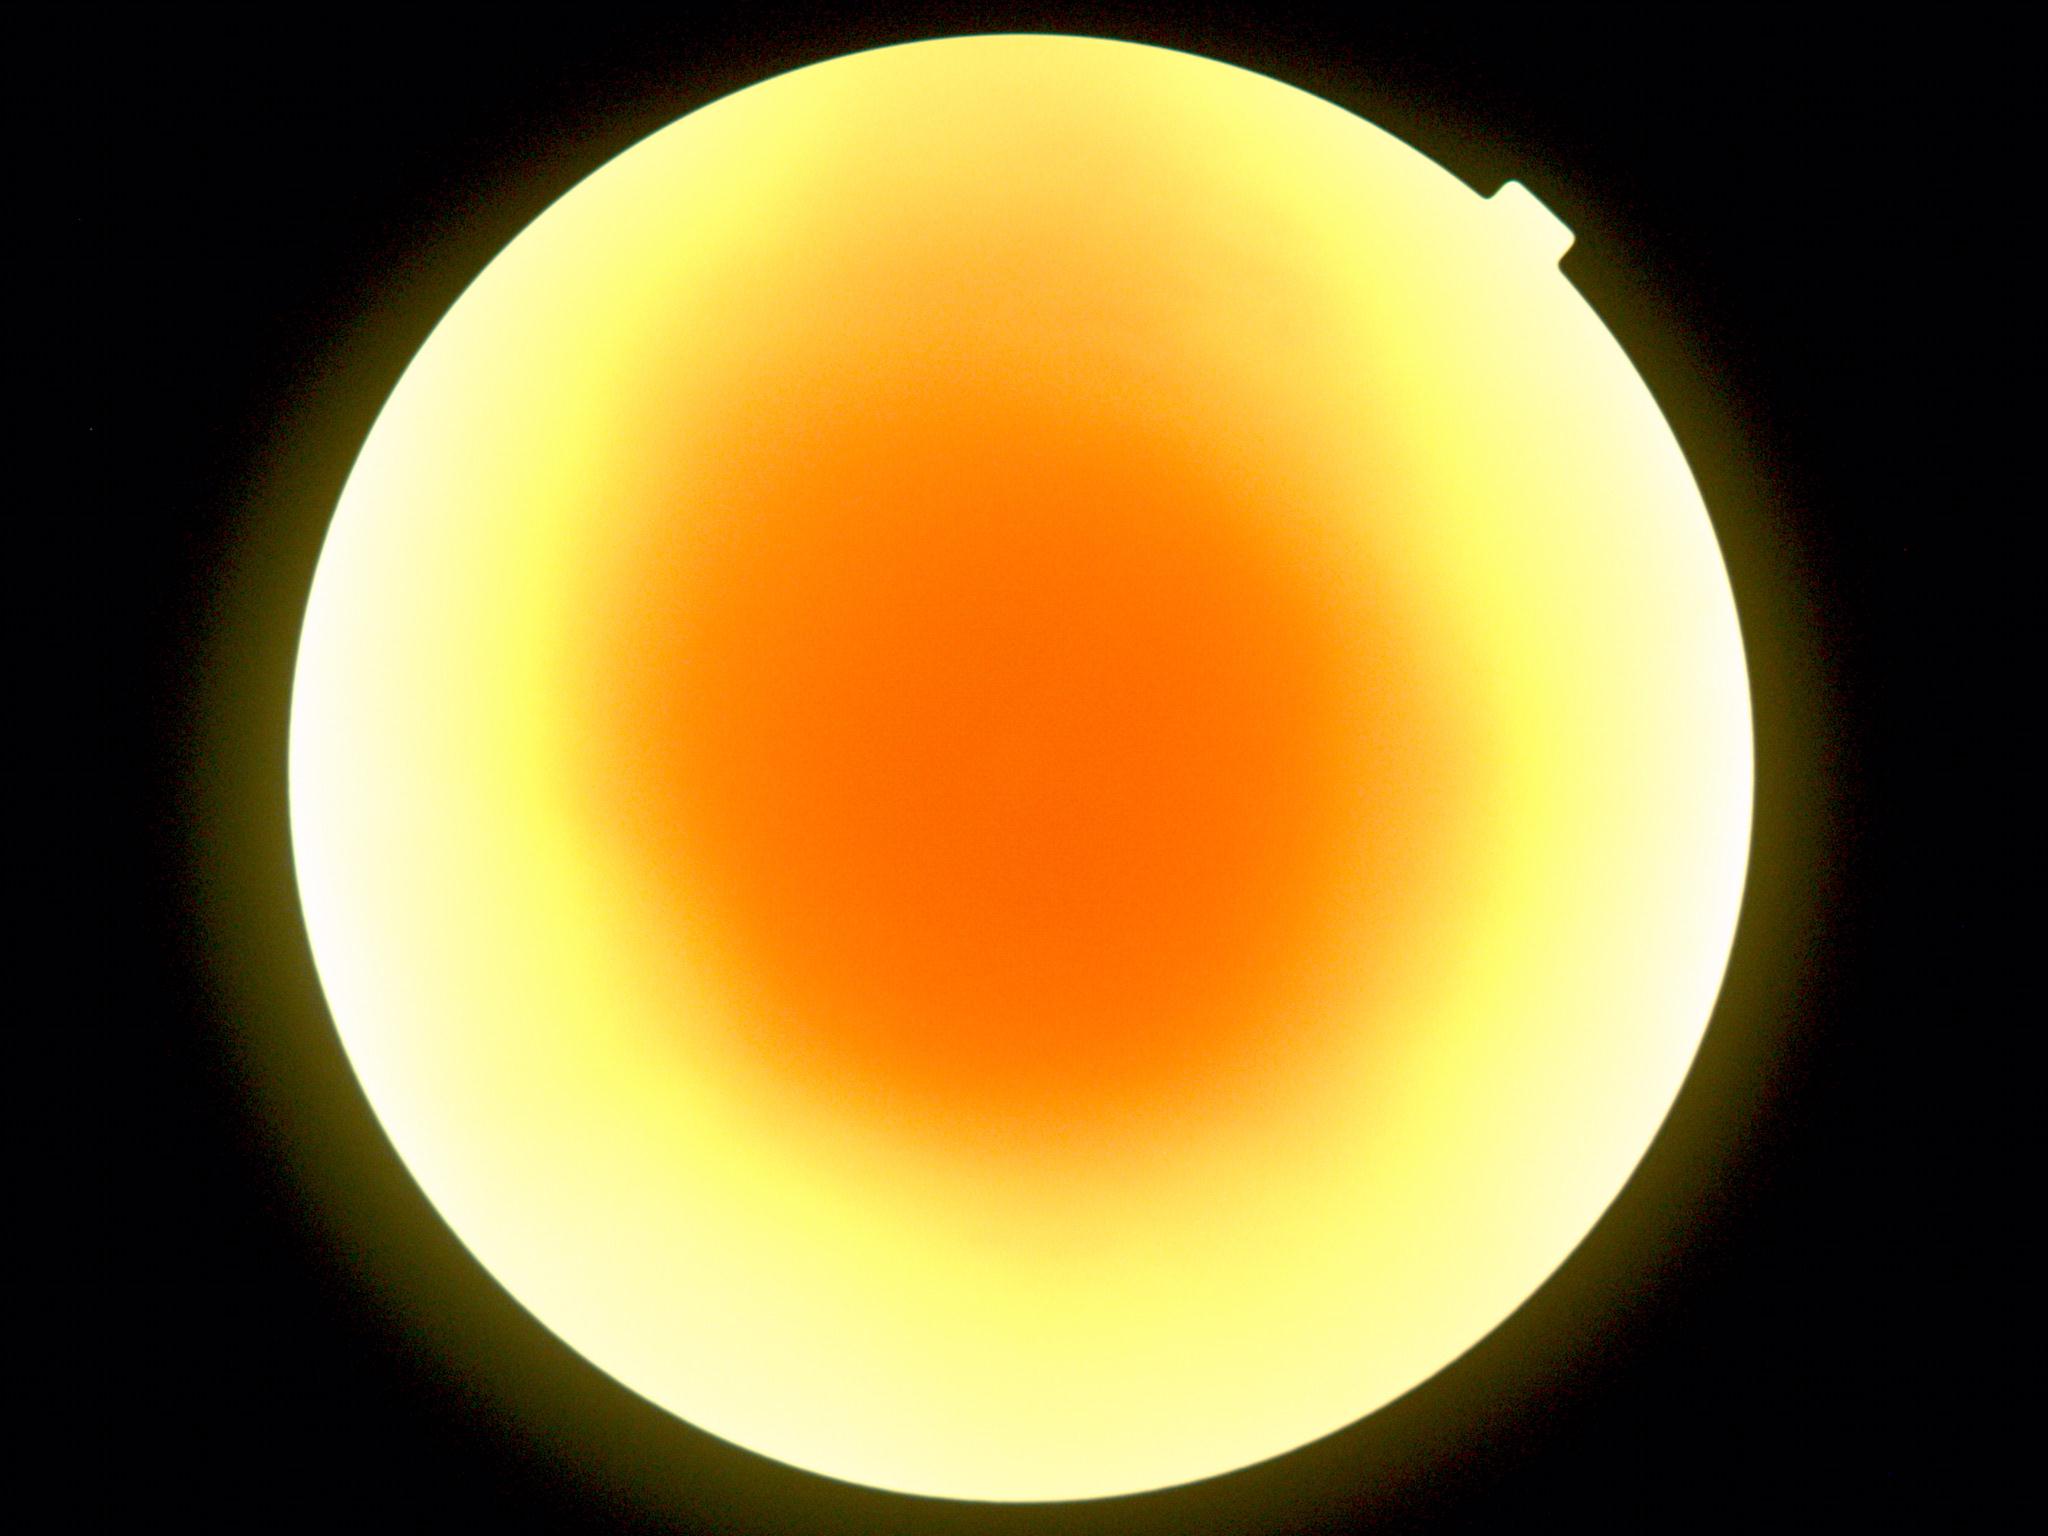

Ungradable image — DR severity cannot be determined. Retinopathy: ungradable.